Image size 2352x1568; 45-degree field of view — 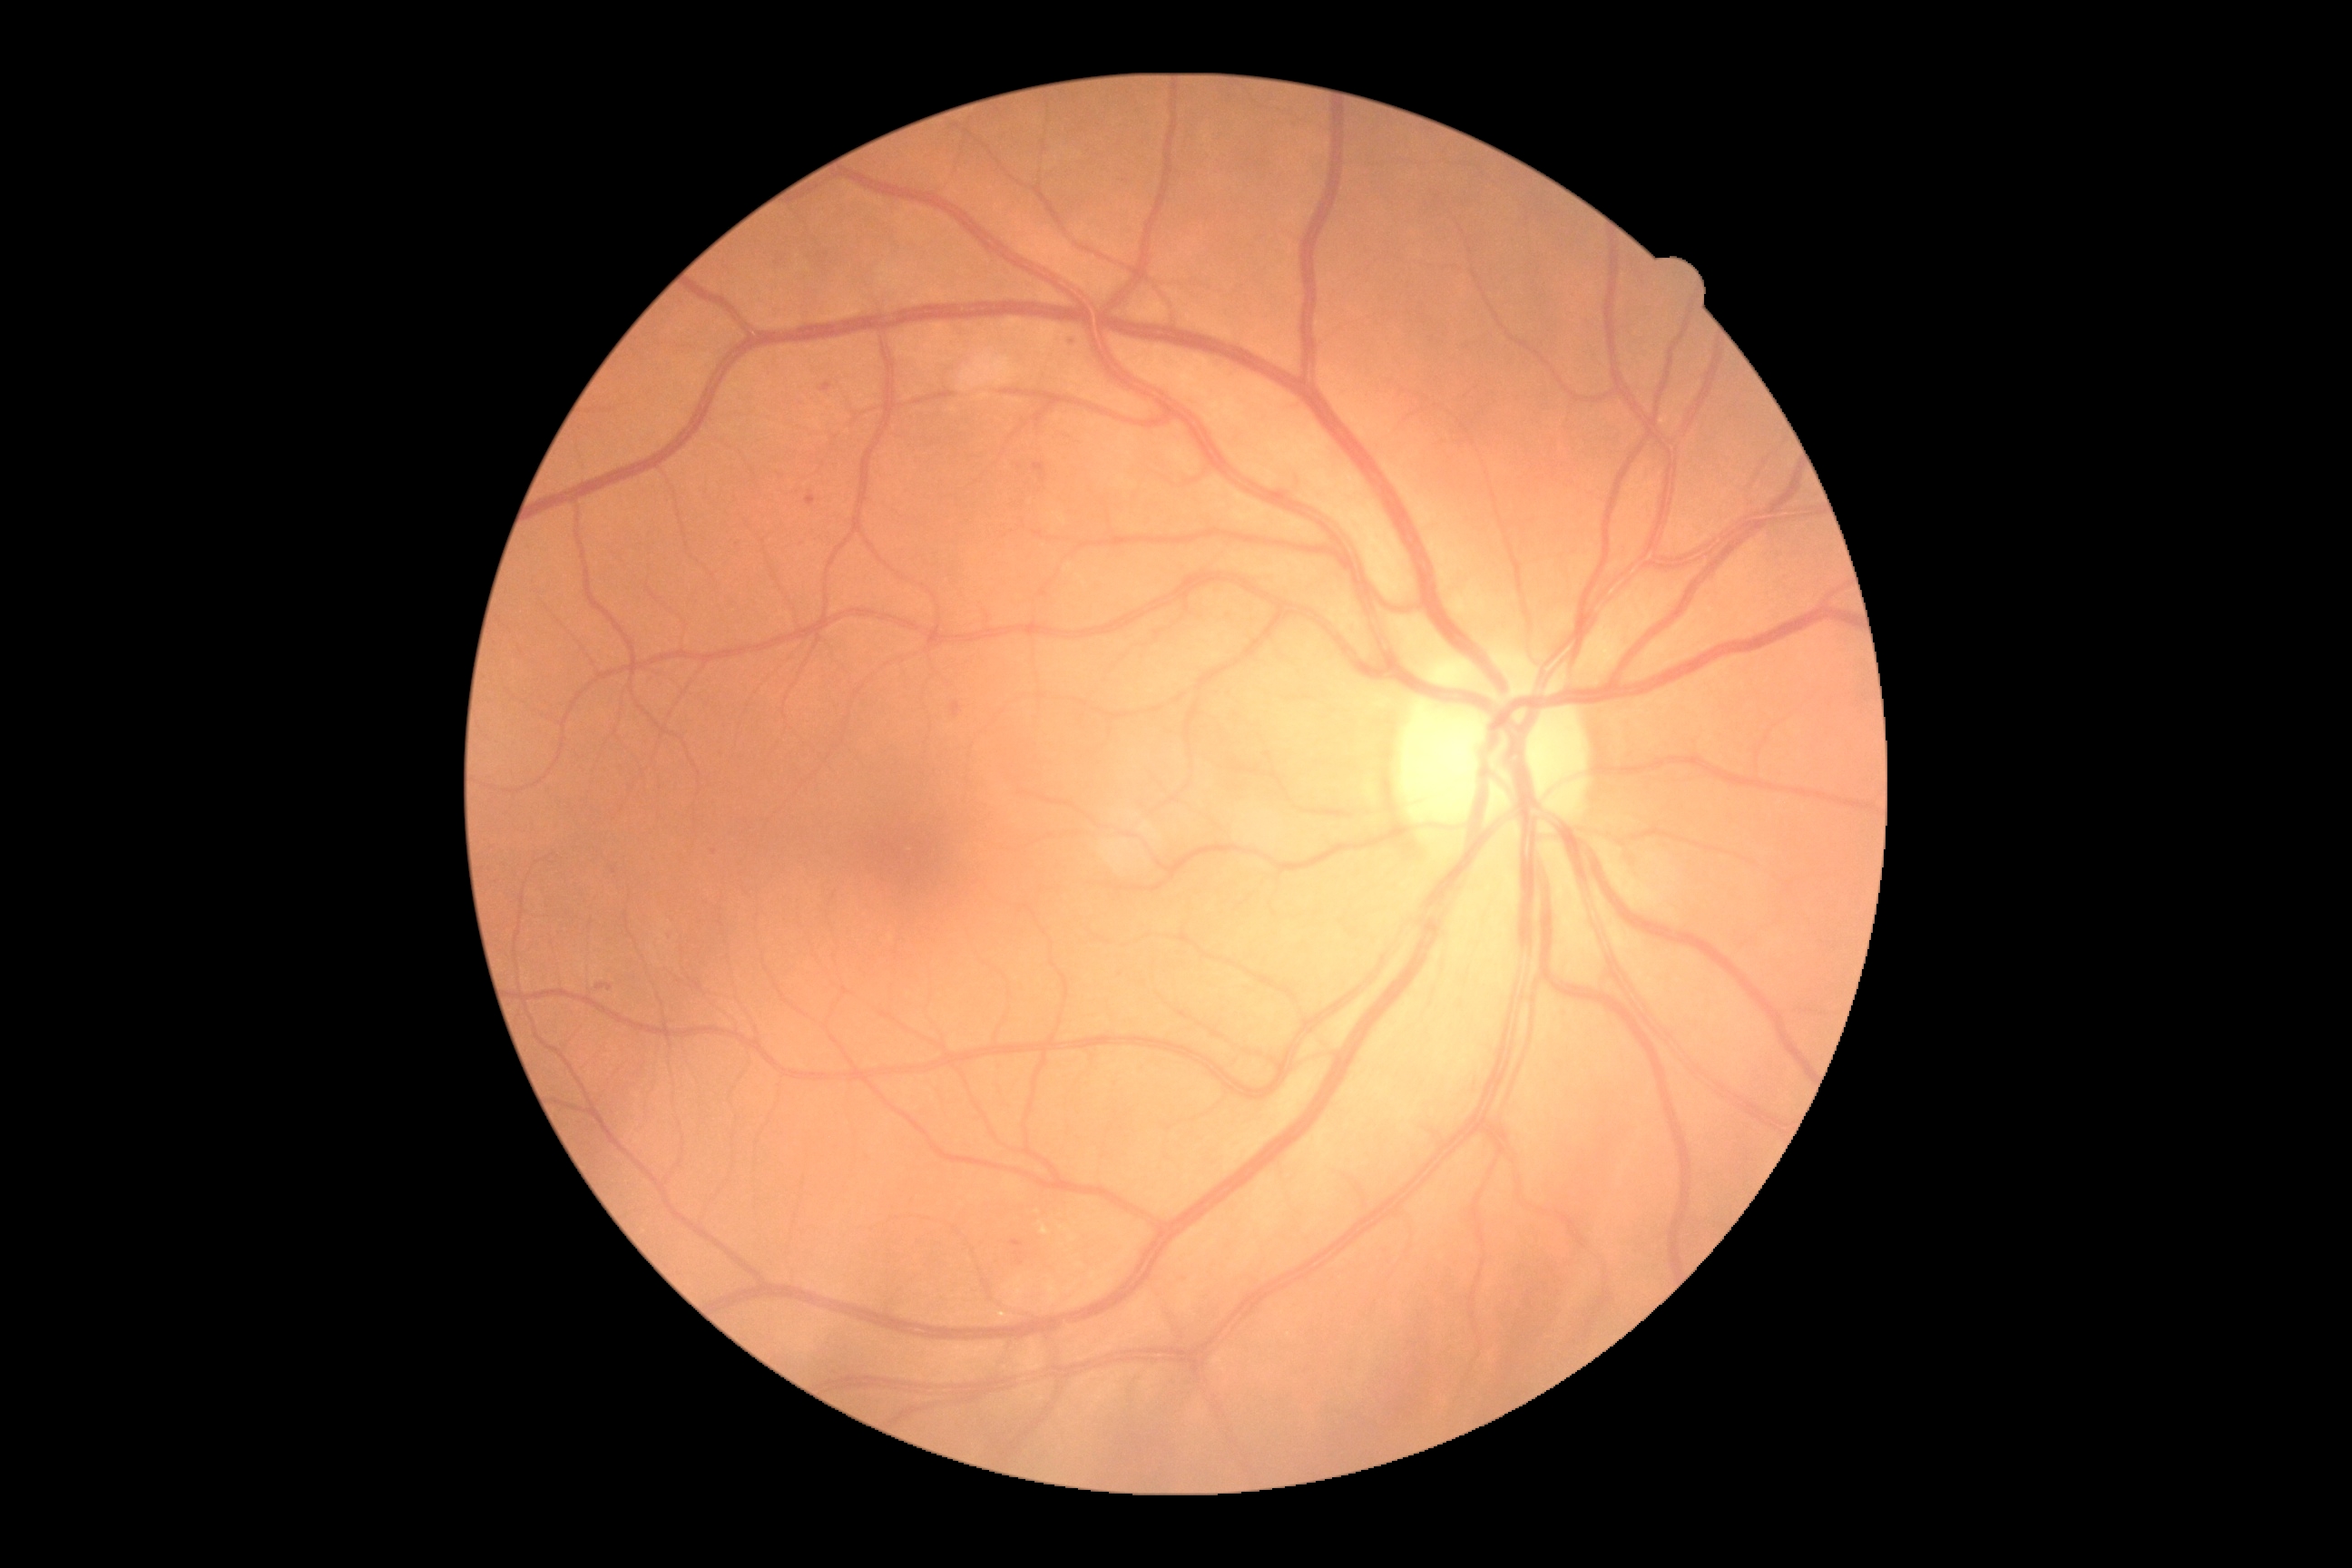
DR is moderate non-proliferative diabetic retinopathy (grade 2)
Selected lesions:
EXs (more not shown): left=1041, top=1226, right=1050, bottom=1235
EXs (small, approximate centers) near <pt>1002,1315</pt>
MAs: left=1066, top=337, right=1075, bottom=344; left=1012, top=1240, right=1023, bottom=1248; left=807, top=491, right=816, bottom=507; left=1035, top=466, right=1043, bottom=471; left=819, top=382, right=832, bottom=393
MAs (small, approximate centers) near <pt>715,852</pt>; <pt>1021,1263</pt>; <pt>669,934</pt>
HEs: left=596, top=985, right=612, bottom=992; left=952, top=703, right=961, bottom=718
SEs: not present